NIDEK AFC-230 fundus camera.
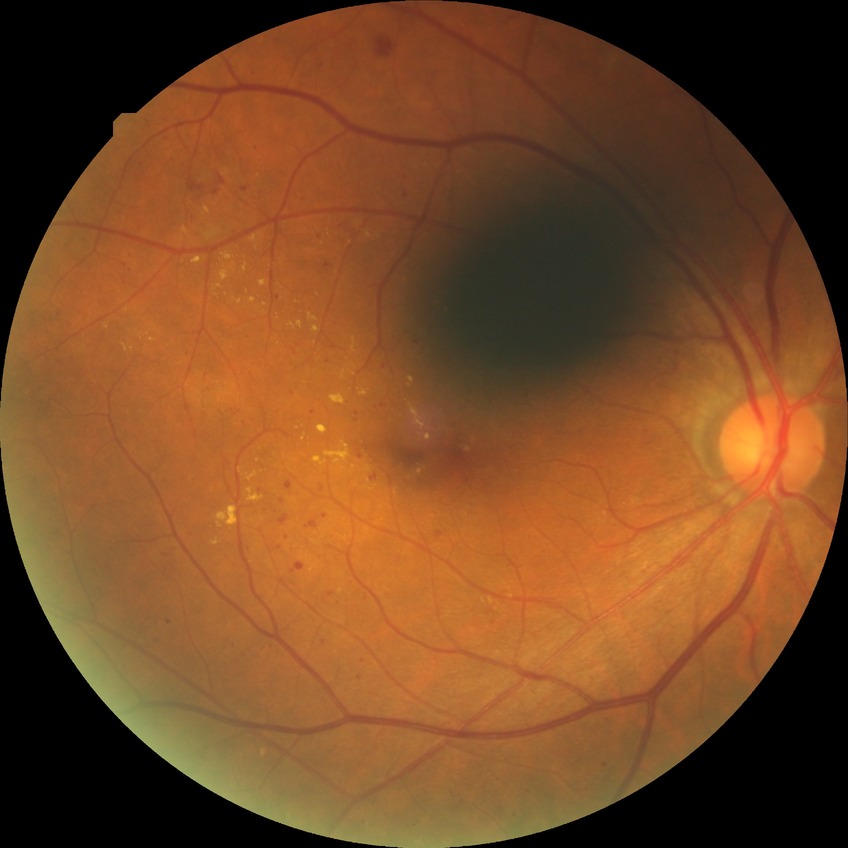 Diabetic retinopathy (DR) is PPDR (pre-proliferative diabetic retinopathy).